1659 x 2212 pixels:
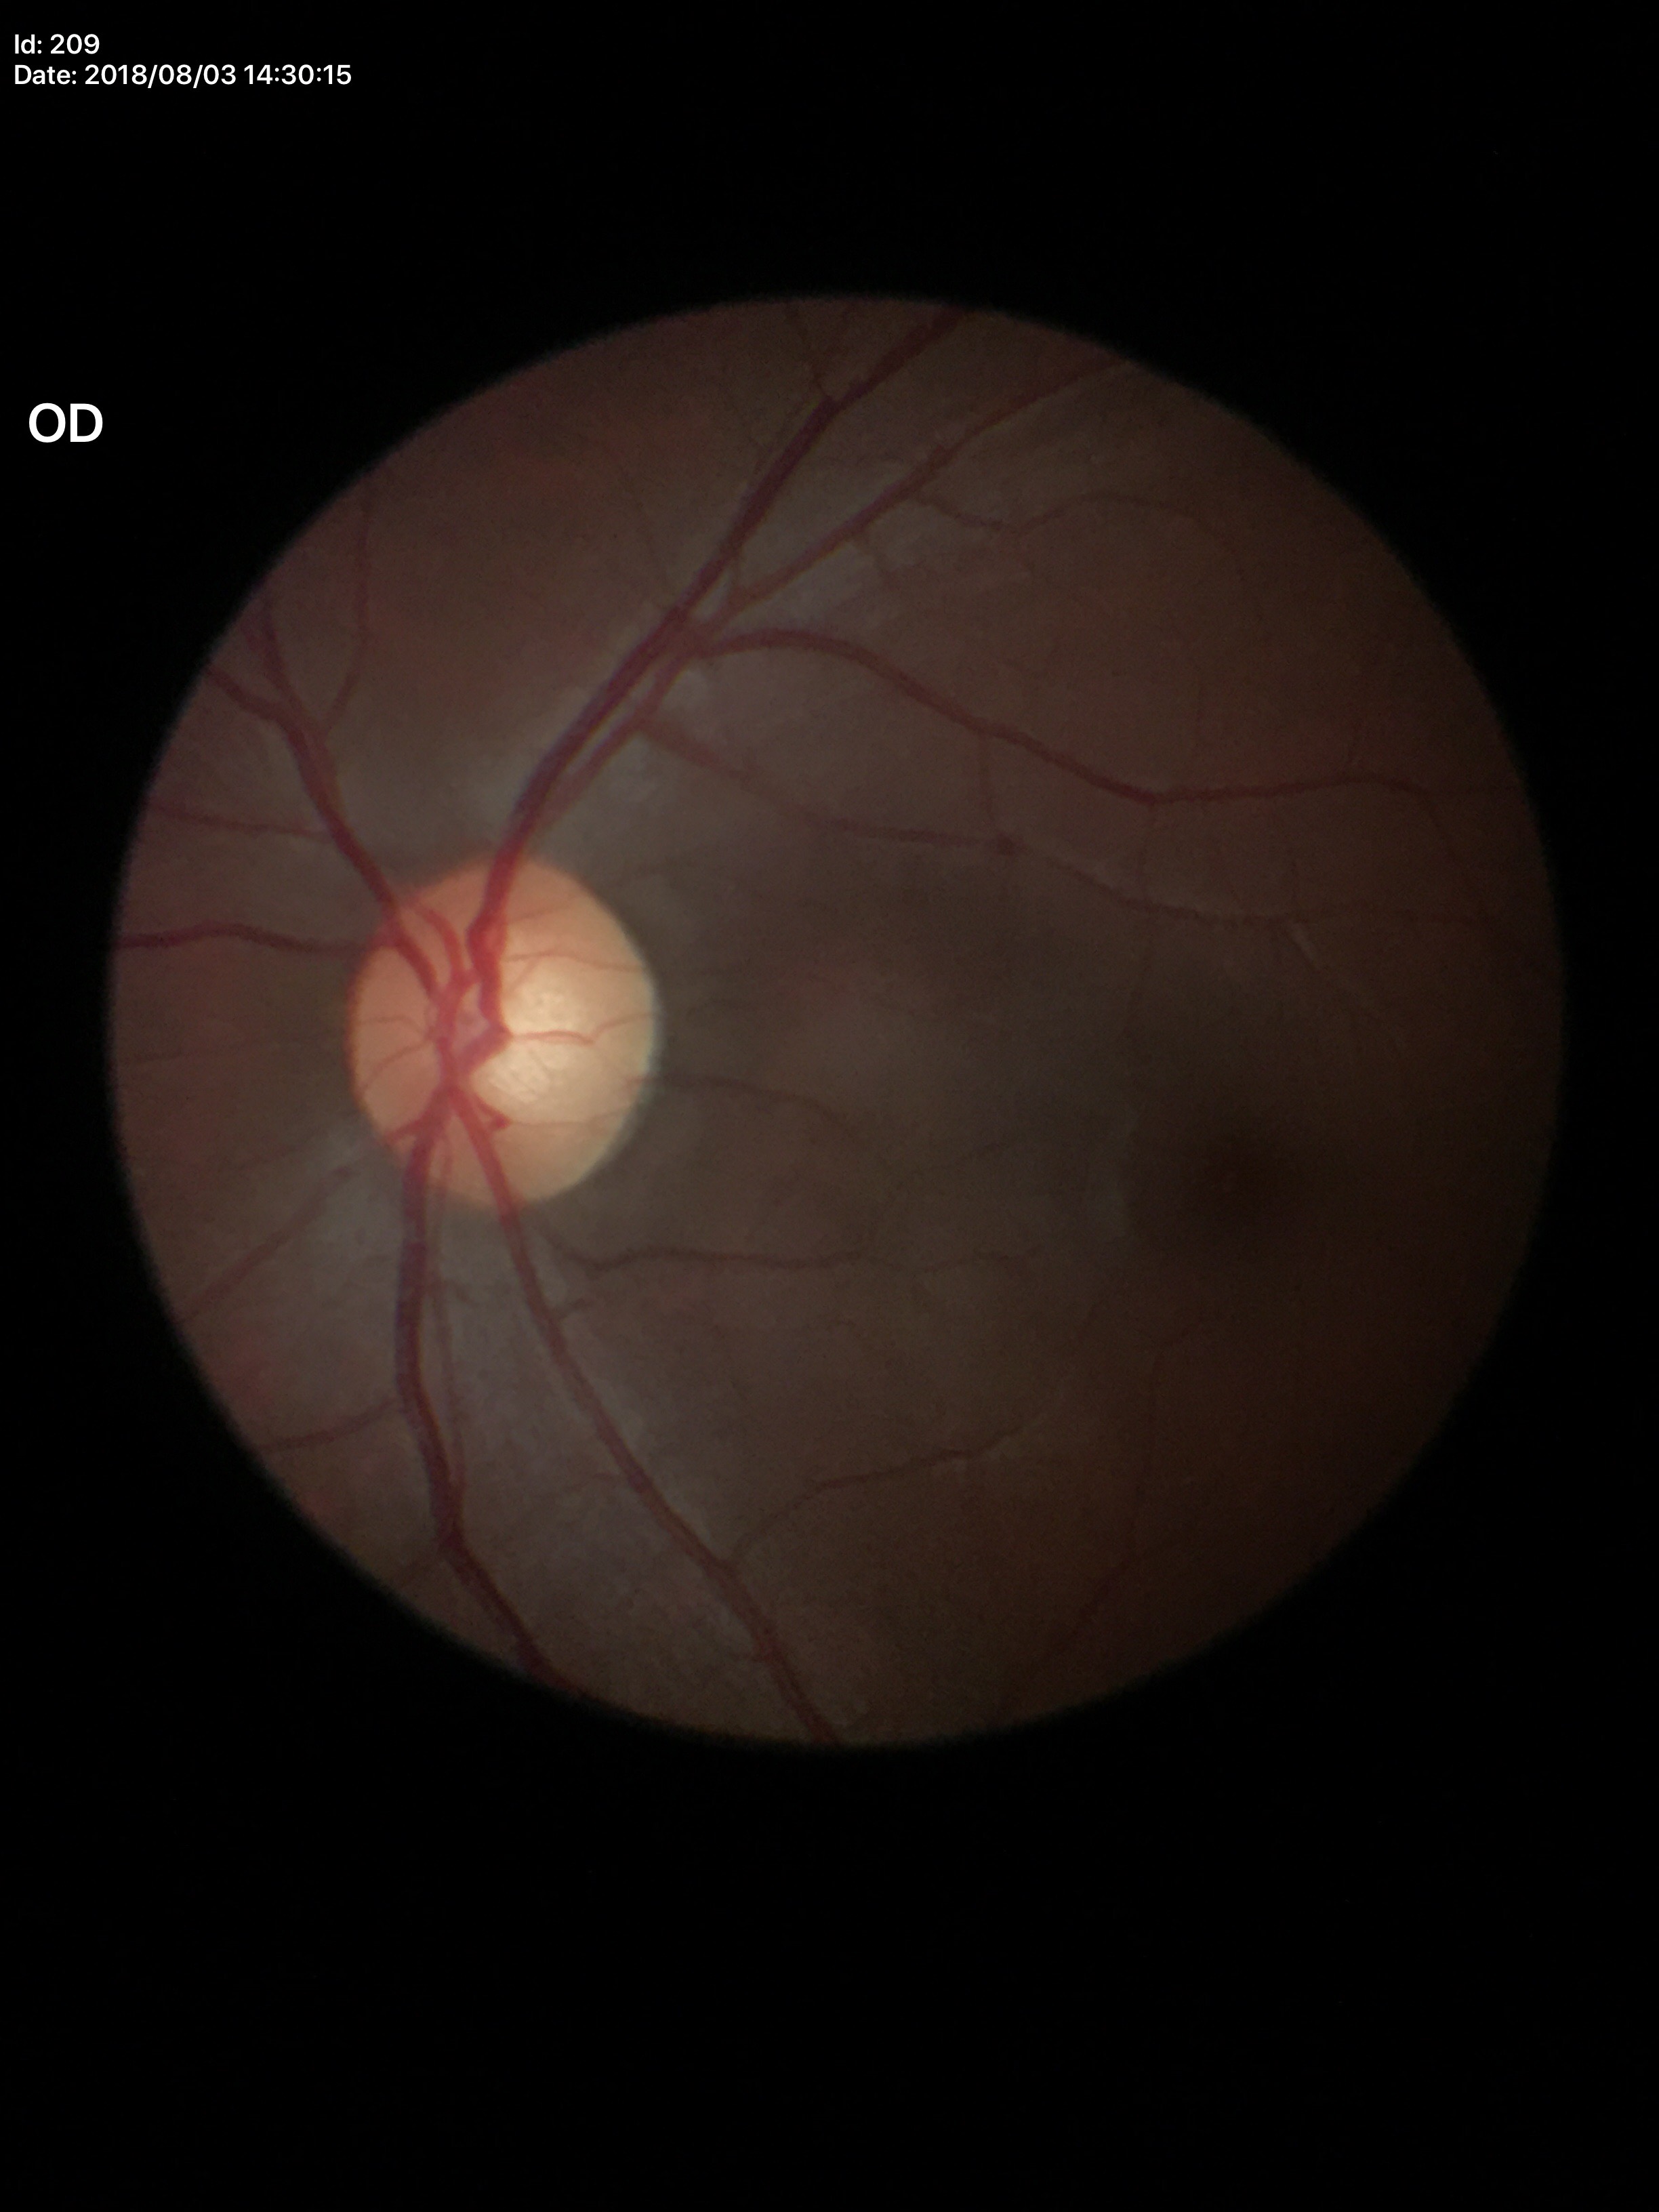 vertical C/D ratio: 0.56 | horizontal cup-to-disc ratio: 0.53 | Glaucoma screening: no suspicious findings (5/5 ophthalmologists in agreement).